NIDEK AFC-230, no pharmacologic dilation, 45-degree field of view, 848x848.
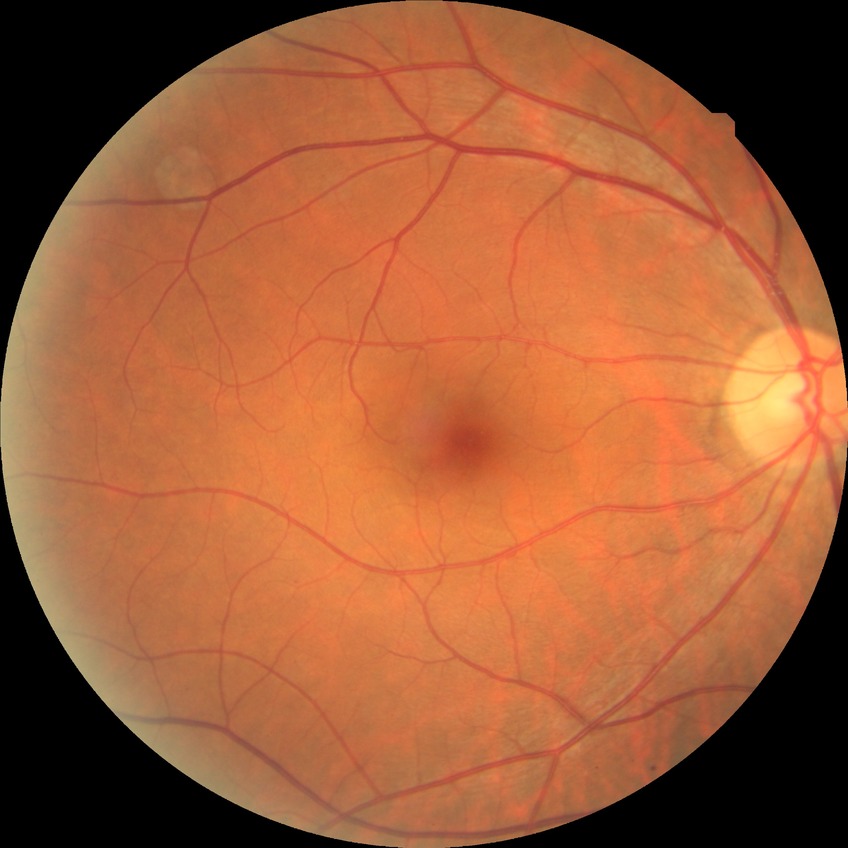

Diabetic retinopathy grade is no diabetic retinopathy.